Color fundus image, 2048x1536, 45° FOV
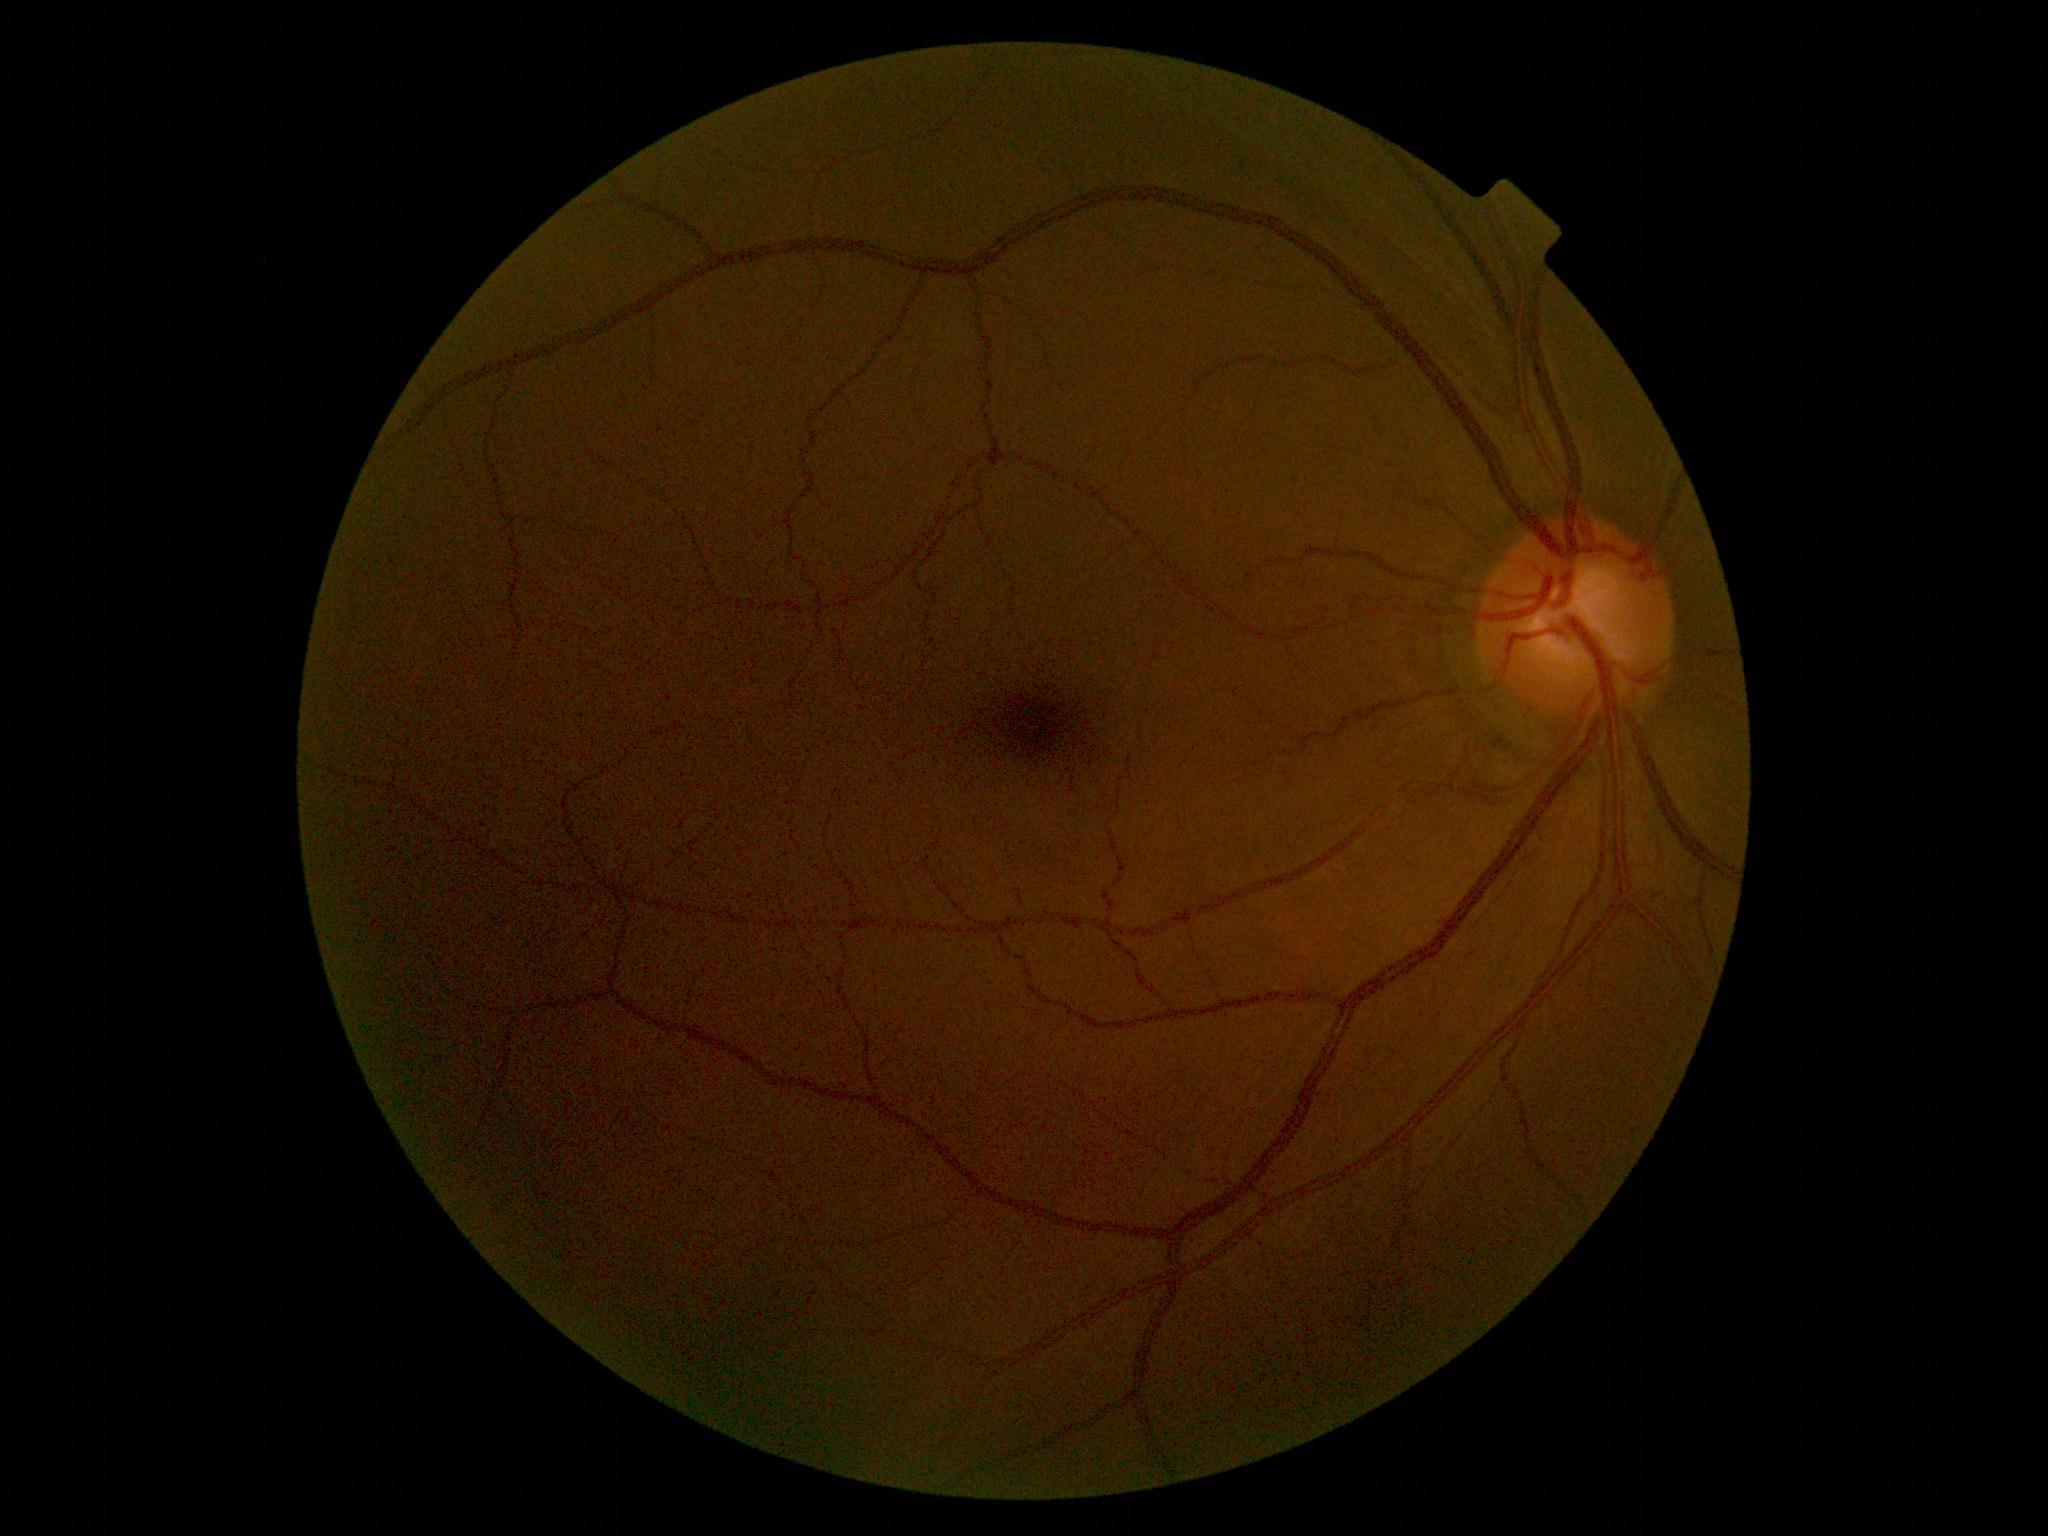 diabetic retinopathy (DR)@0.